45-degree field of view.
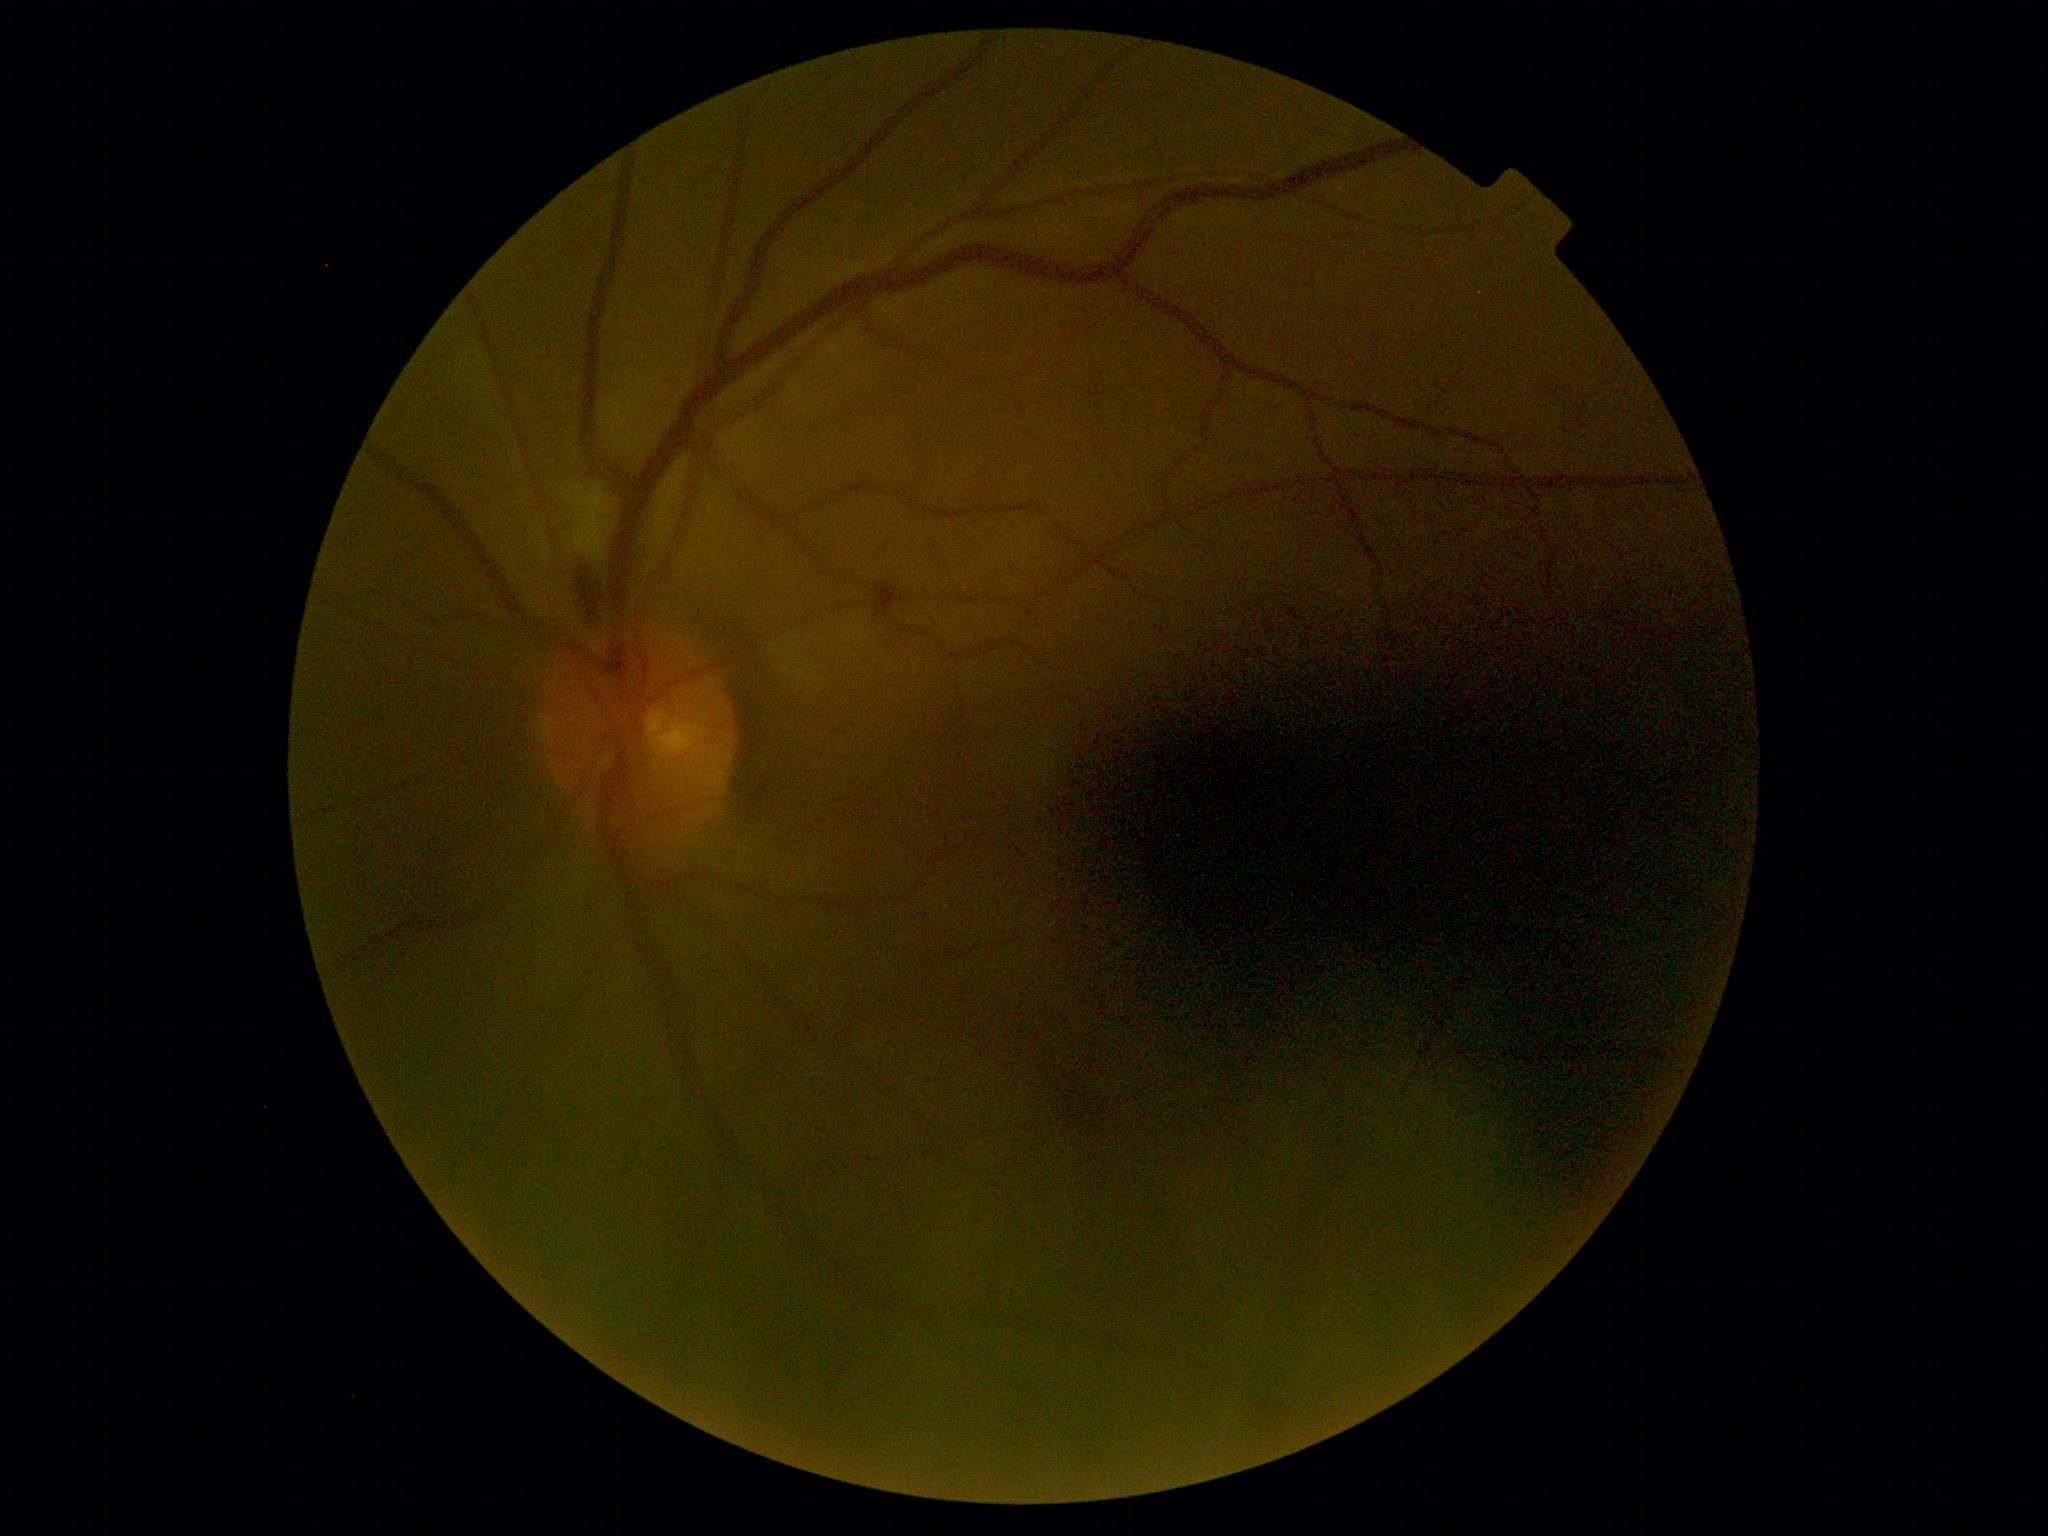
DR is moderate non-proliferative diabetic retinopathy (grade 2). Disease class: non-proliferative diabetic retinopathy.